640 by 480 pixels; wide-field fundus photograph of an infant:
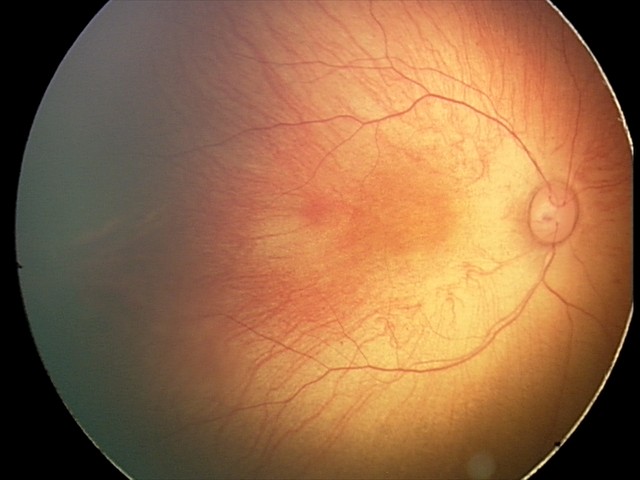 Series diagnosed as retinal hemorrhages.